848 x 848 pixels.
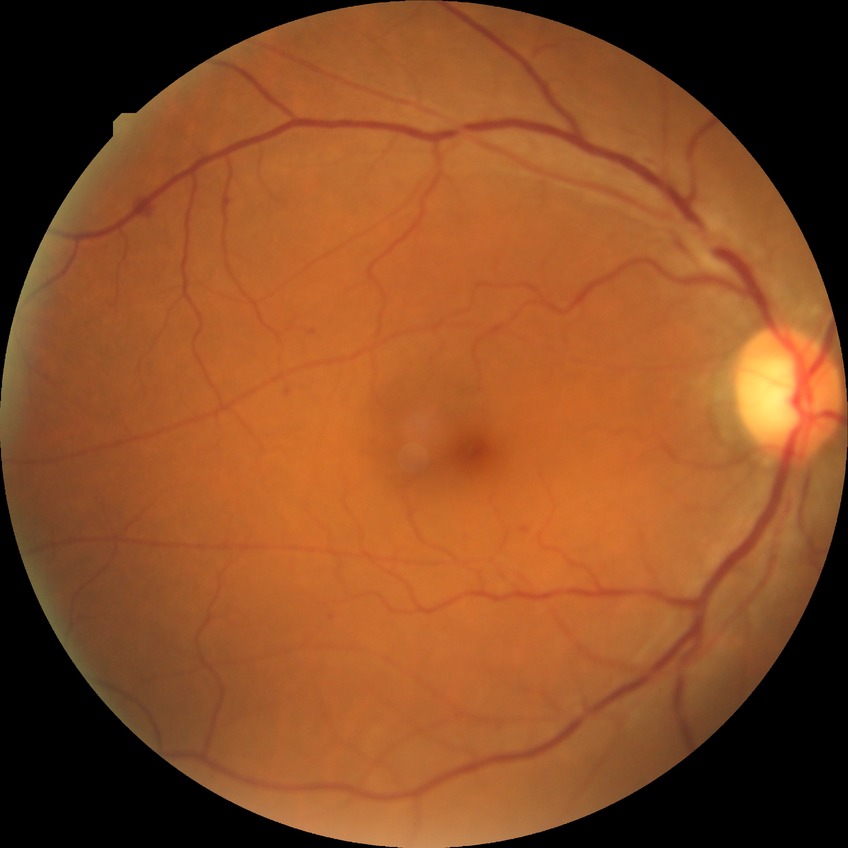 Modified Davis grading is simple diabetic retinopathy.